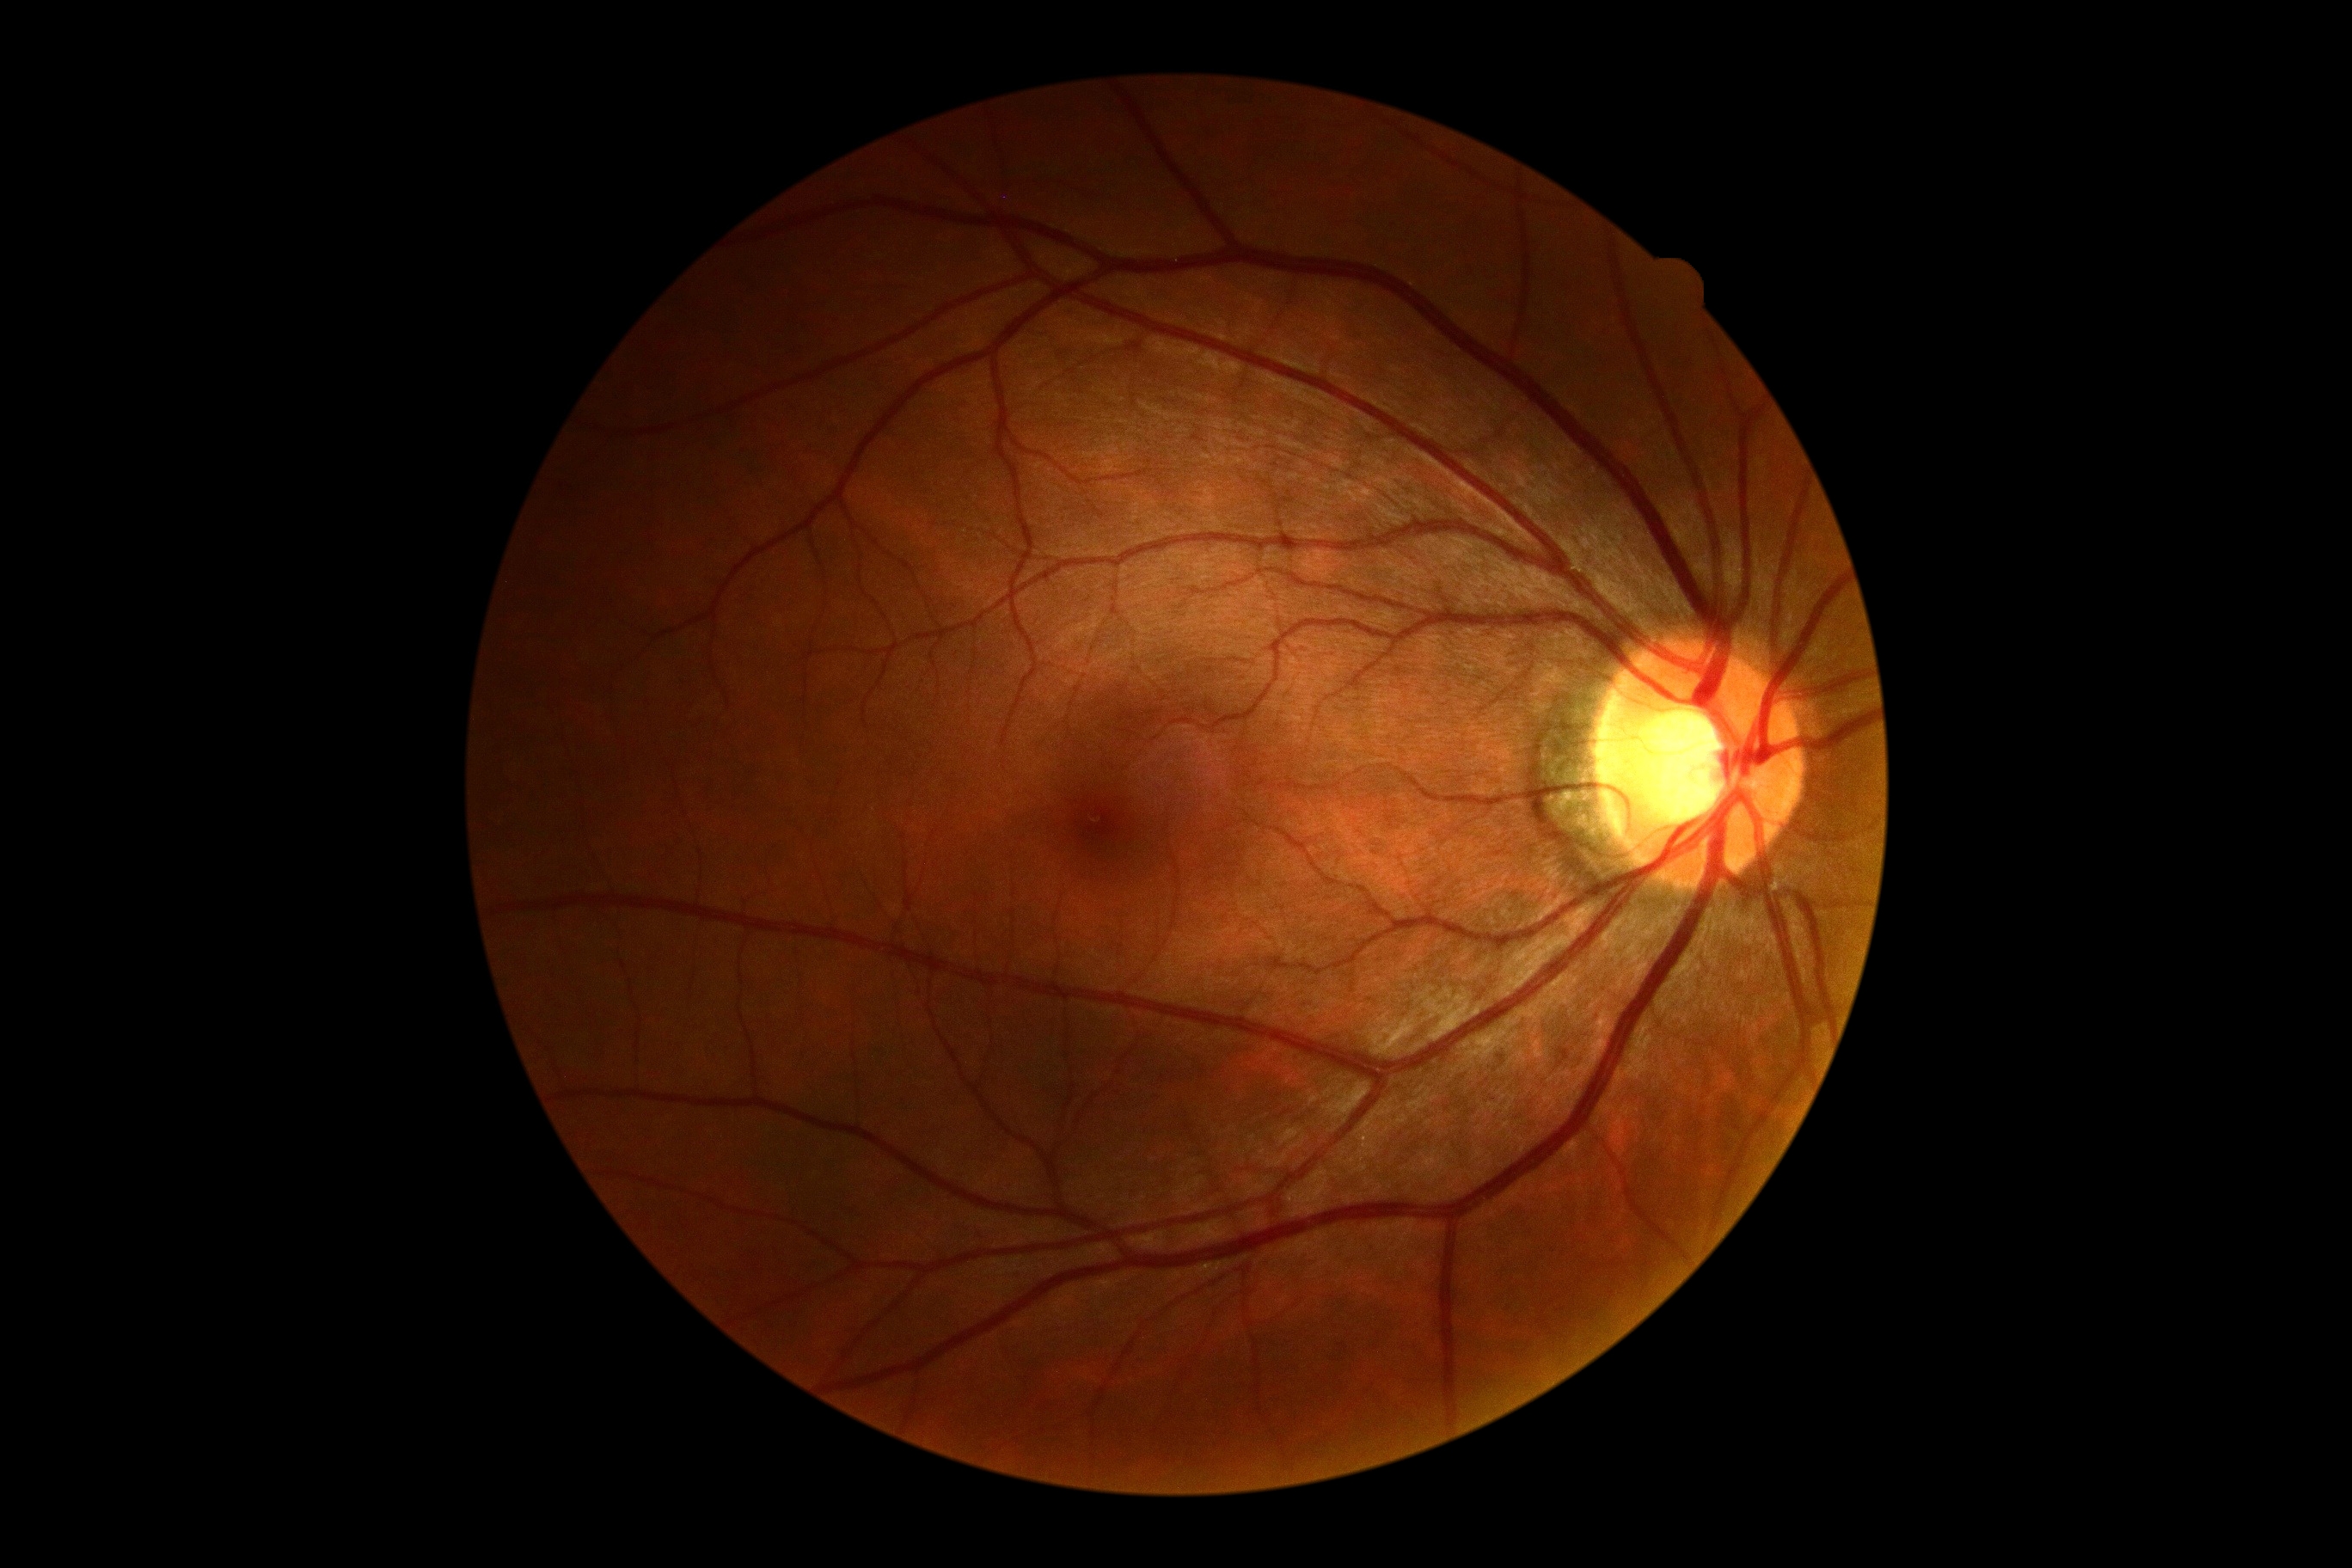 diabetic retinopathy grade: 0